Wide-field fundus photograph from neonatal ROP screening:
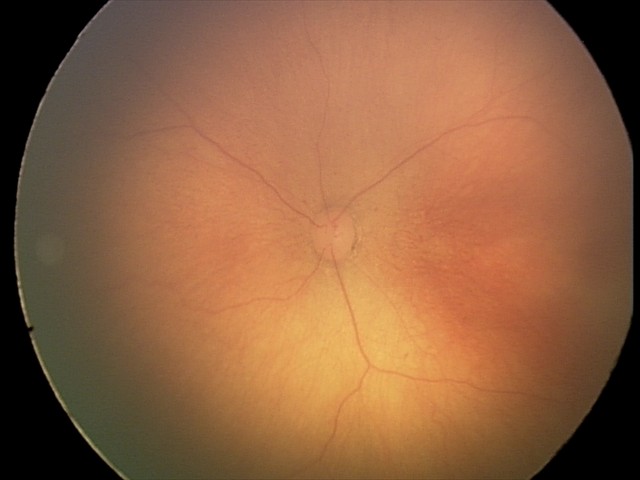
ROP = stage 0 — incomplete retinal vascularization without a demarcation line, plus disease = absent.